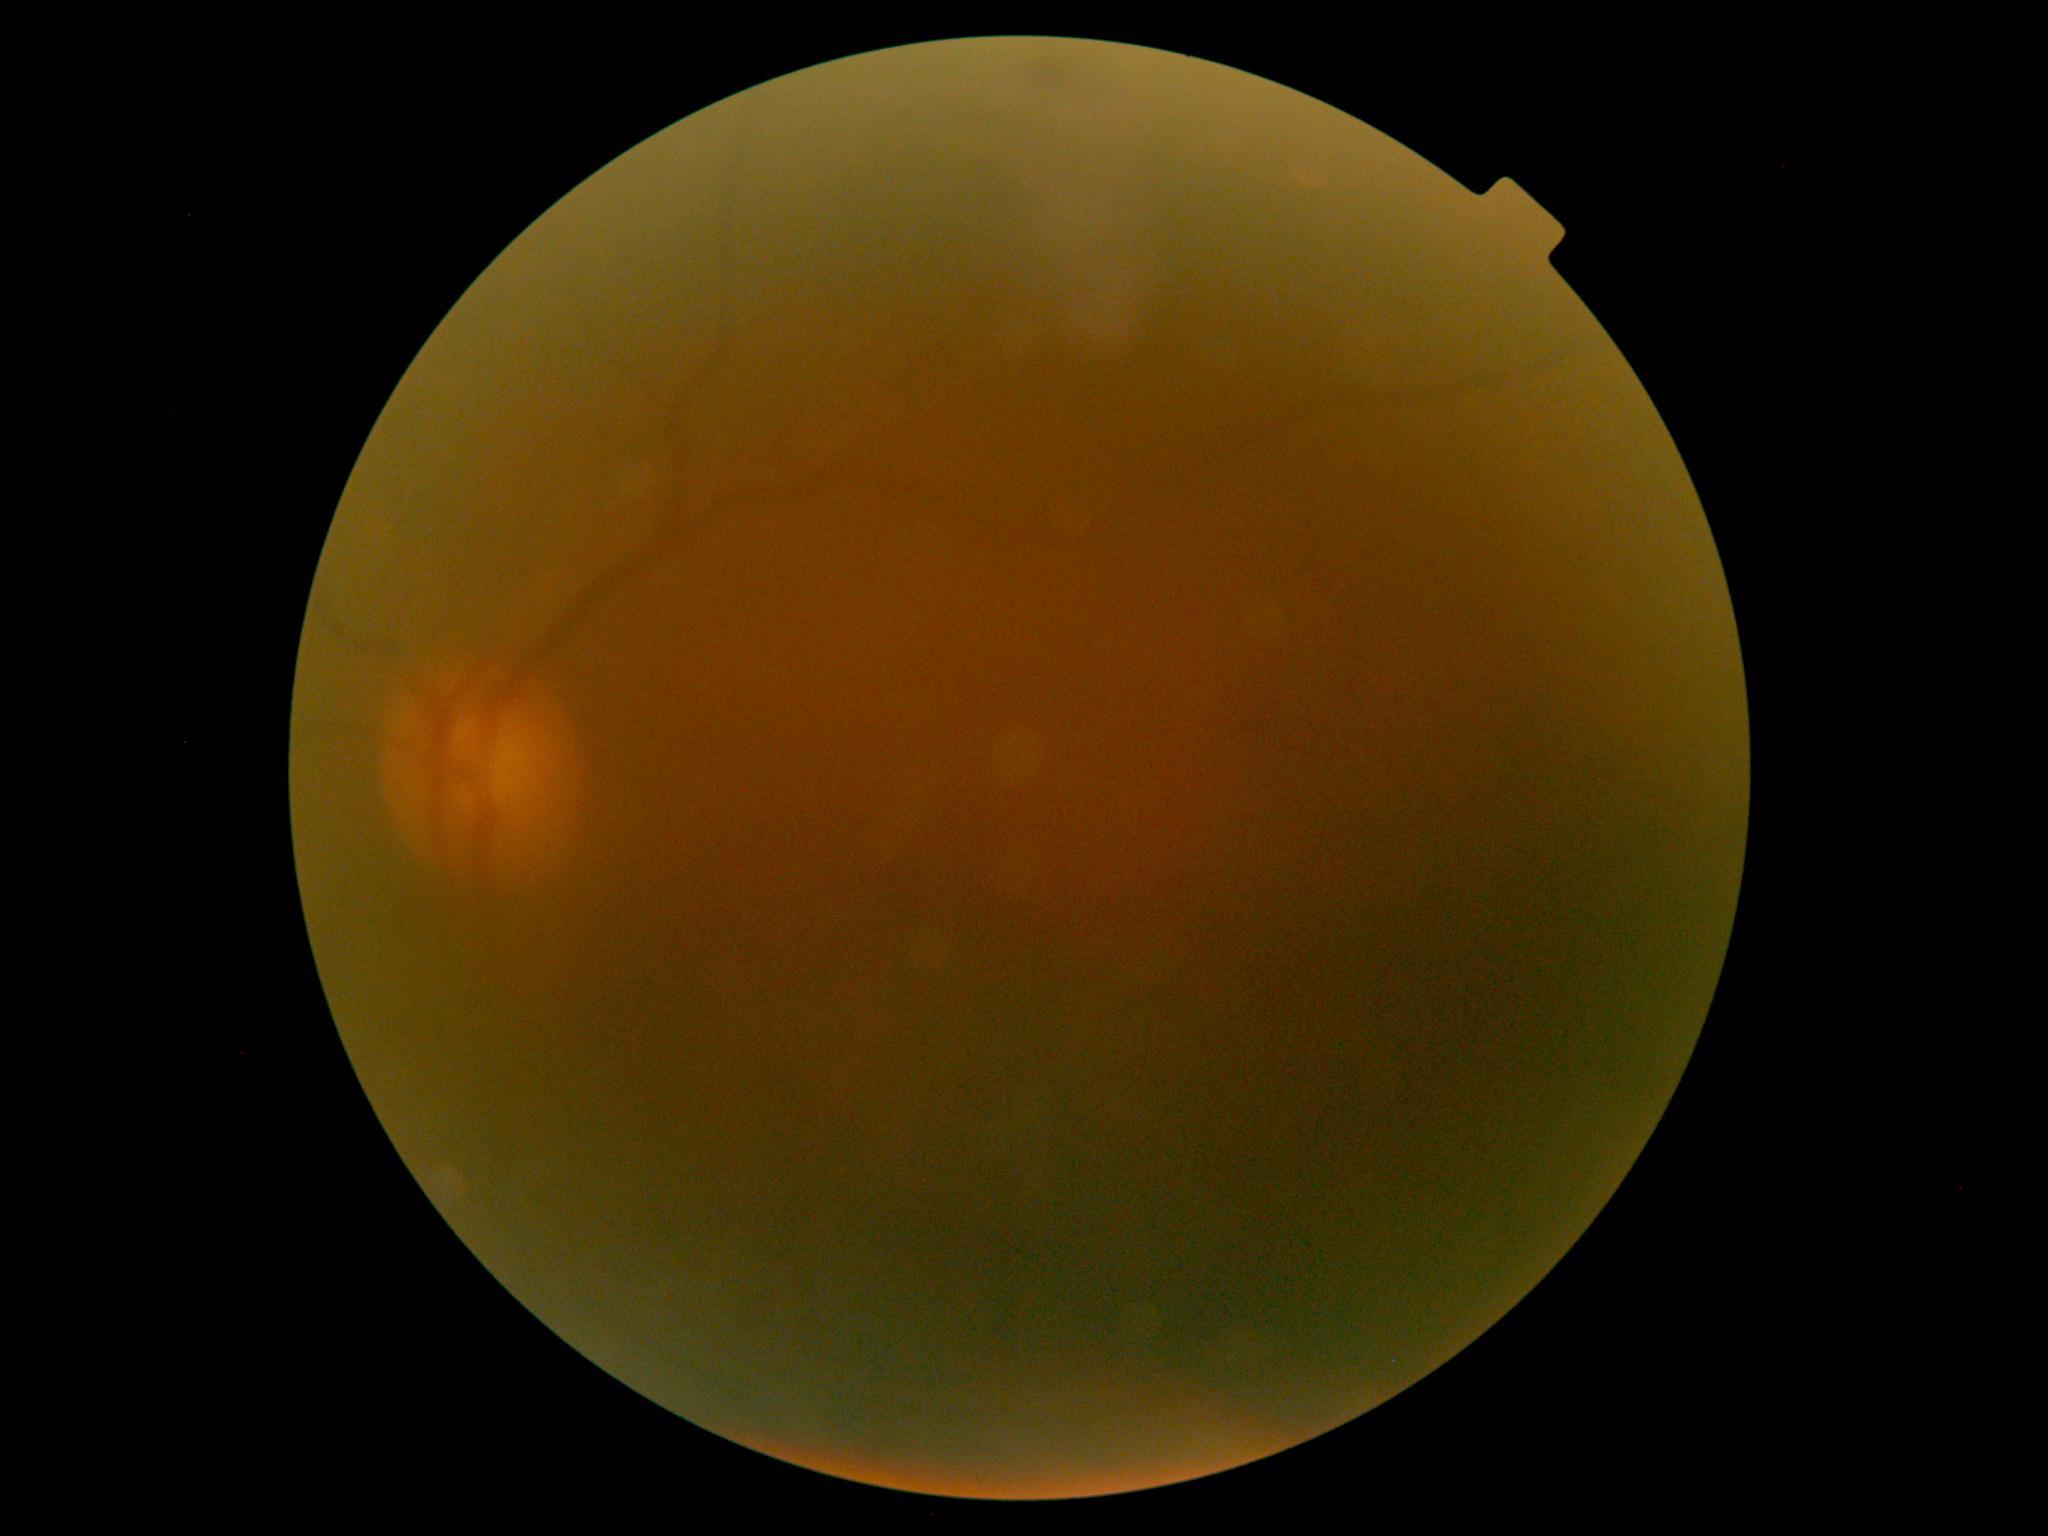
Image quality is insufficient for diabetic retinopathy assessment. DR grade is ungradable.